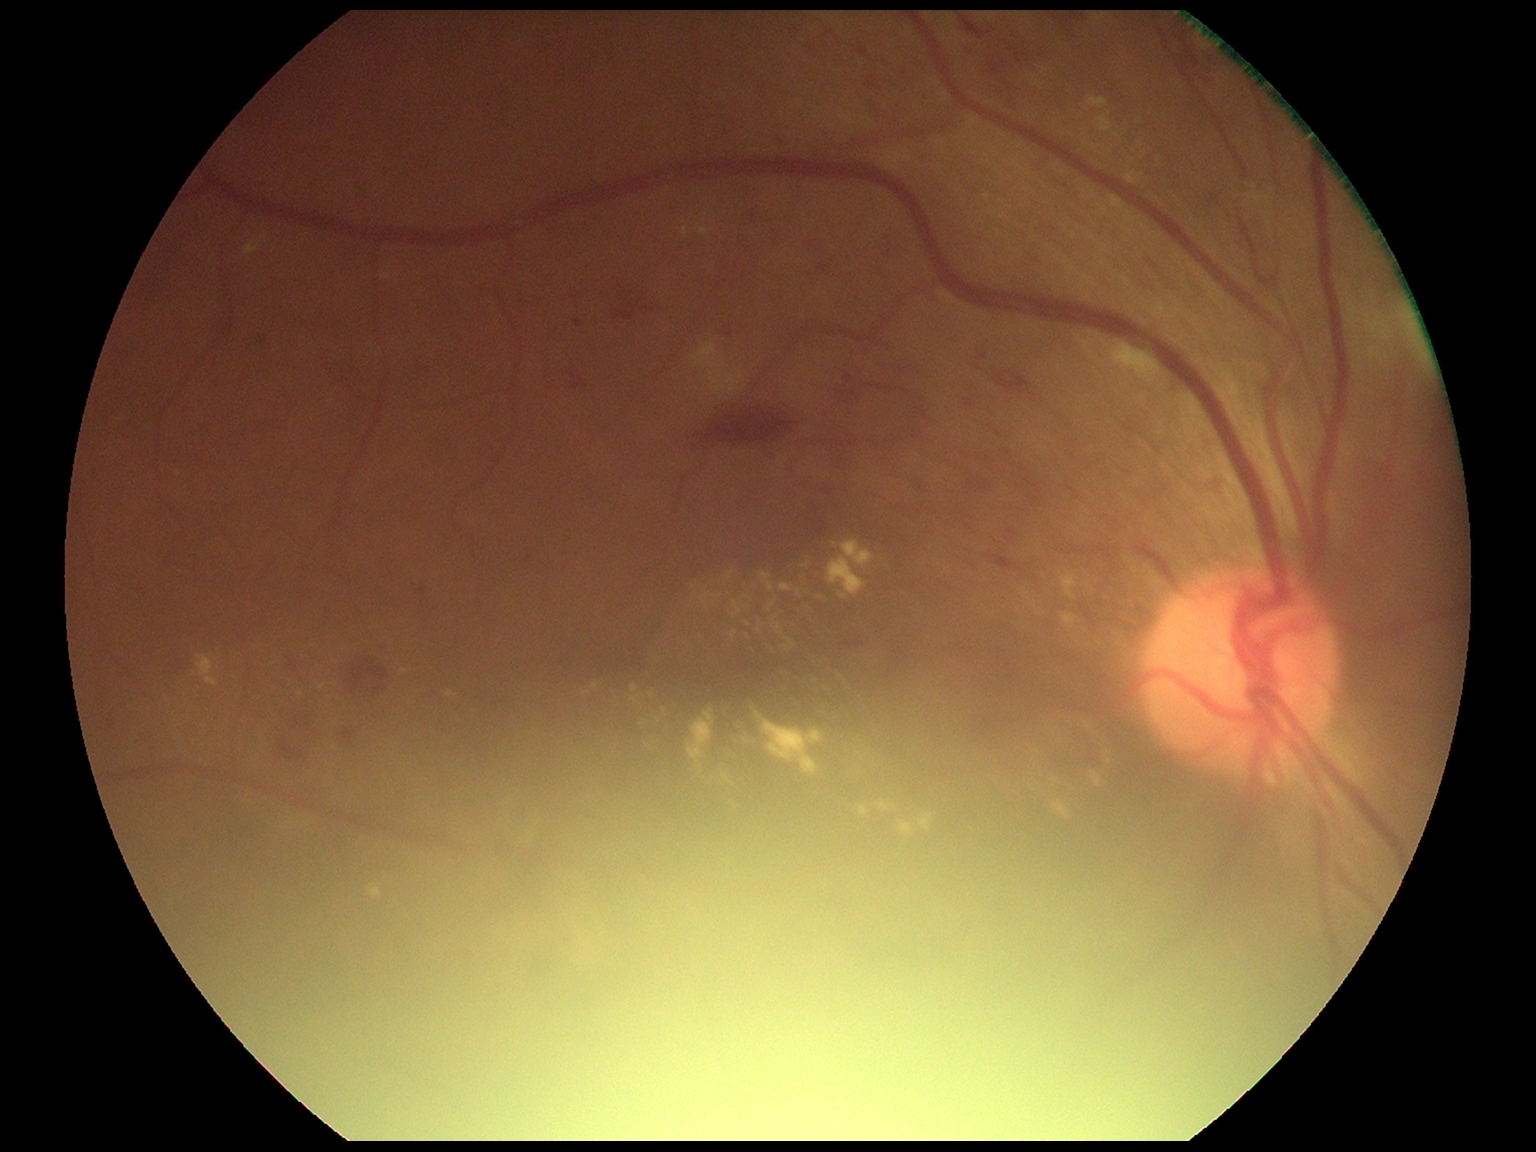
Diabetic retinopathy (DR) is moderate non-proliferative diabetic retinopathy (grade 2).